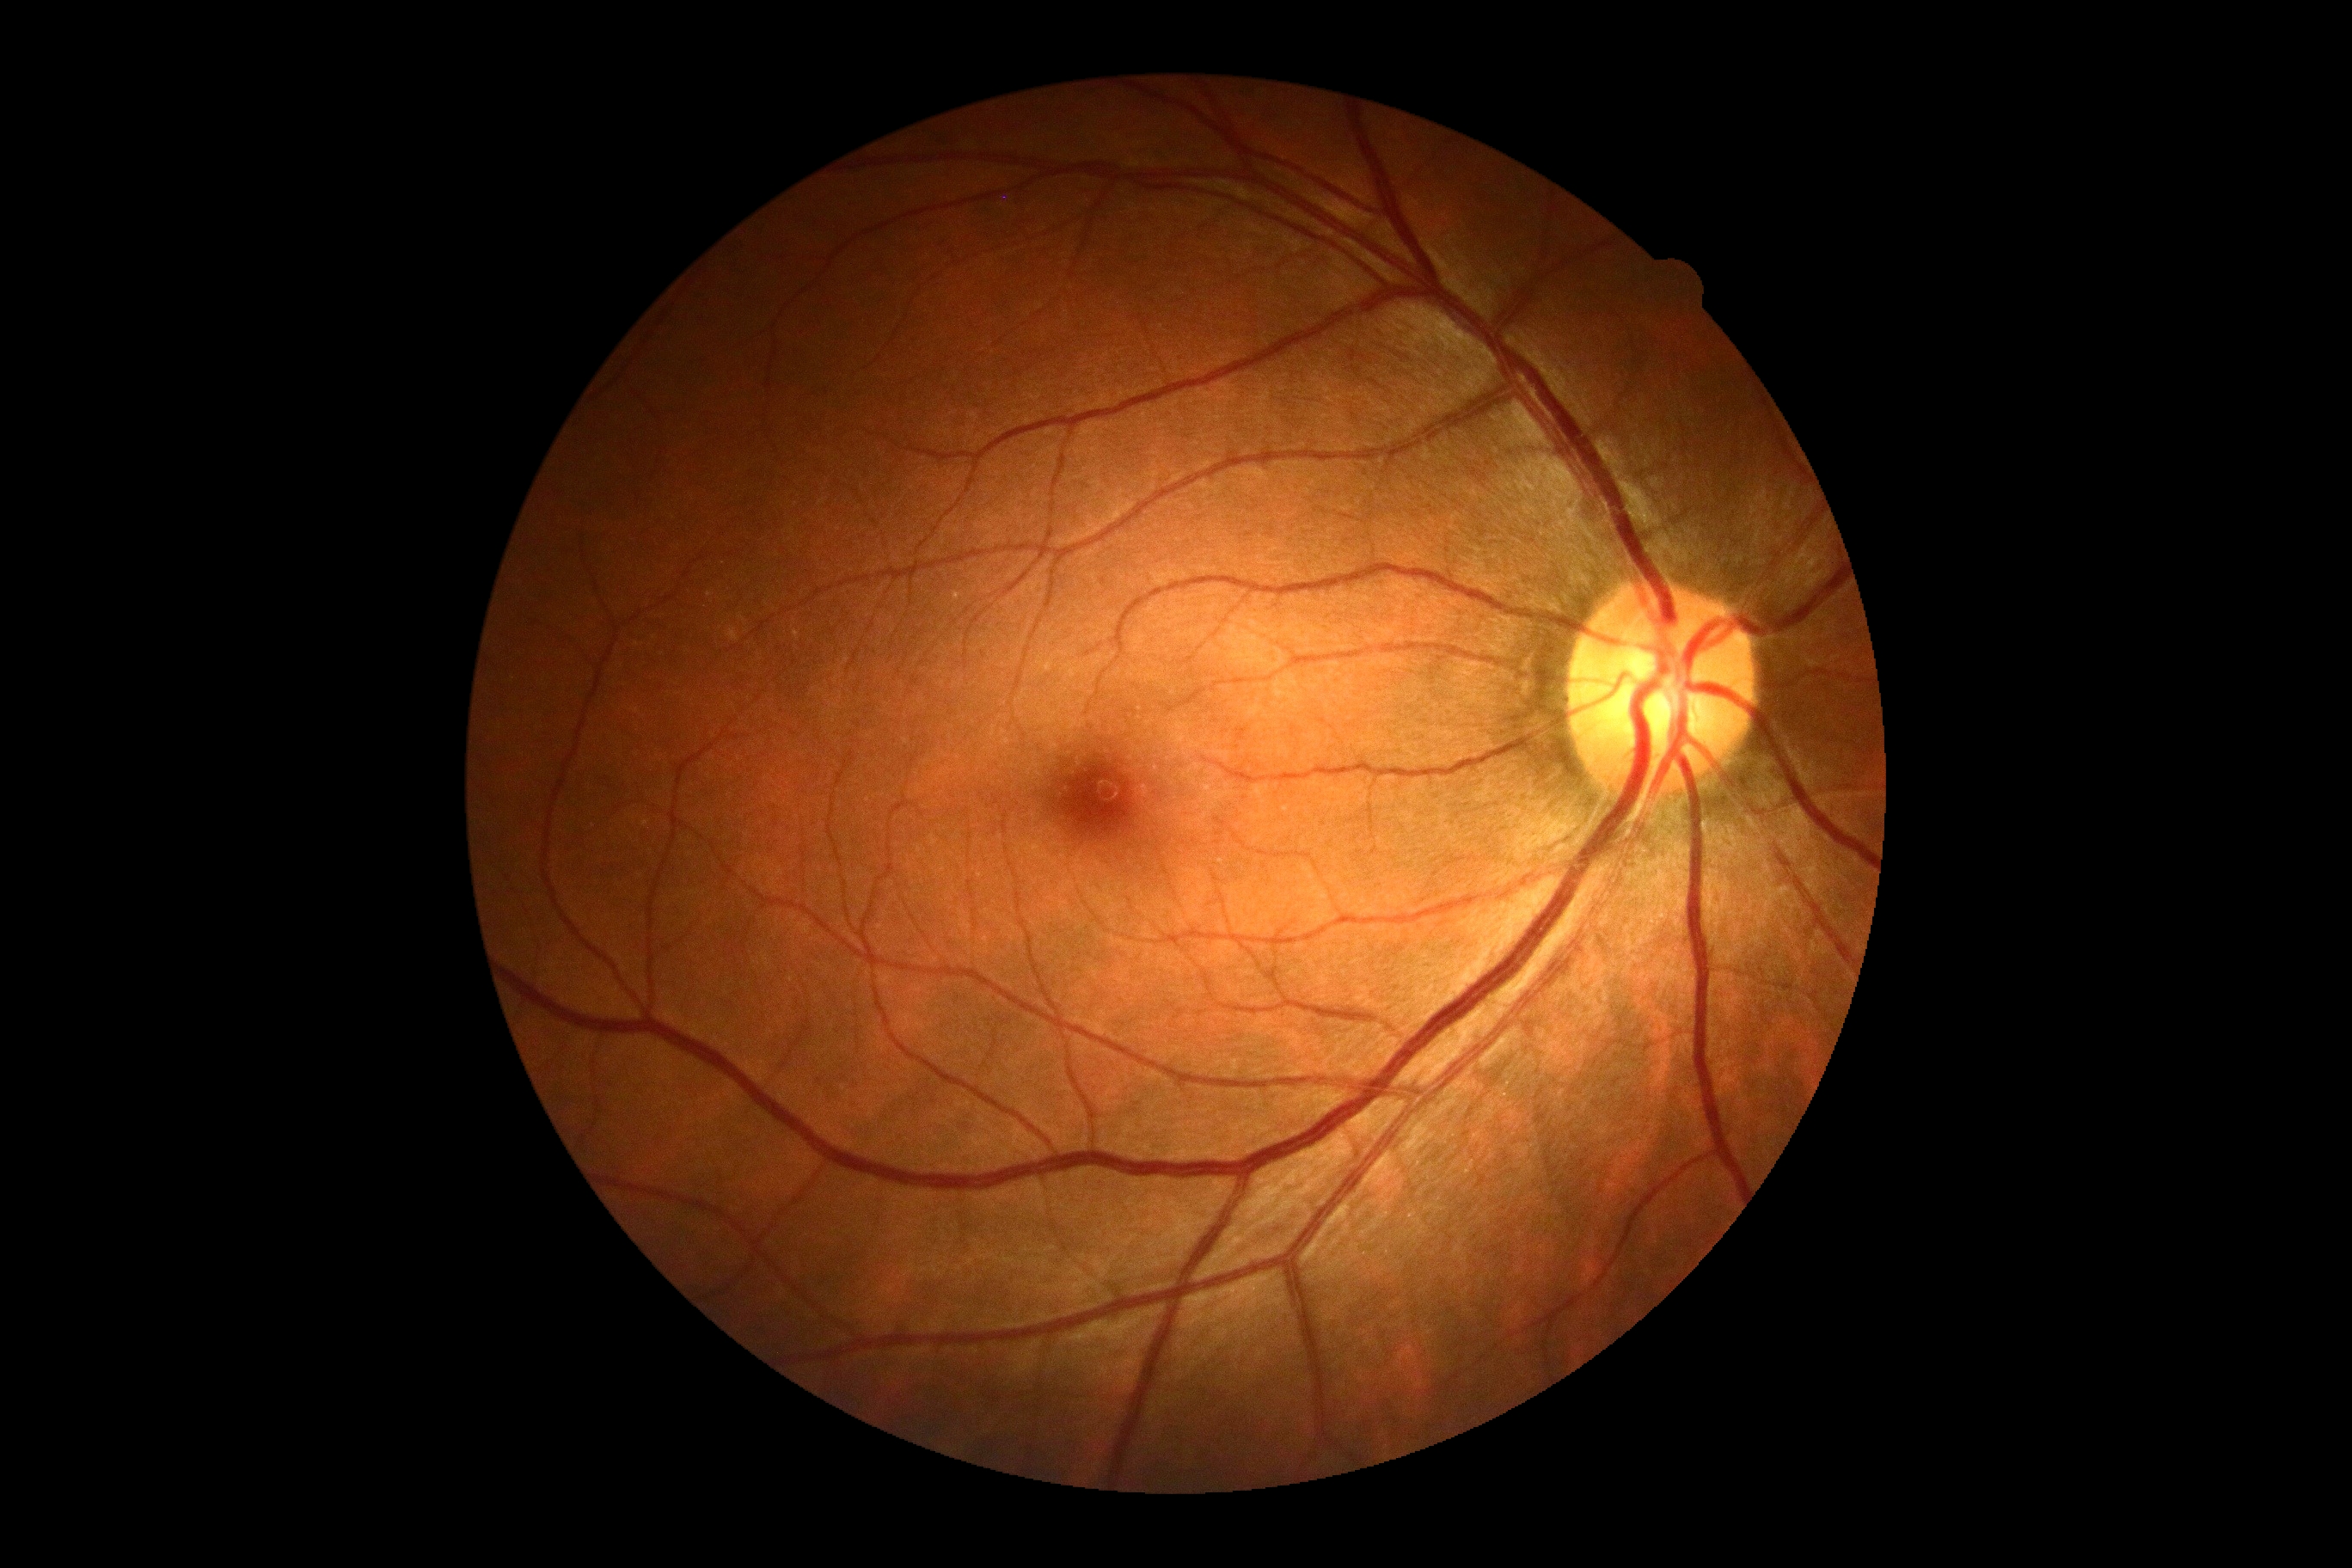
* DR grade — 0/4 — no visible signs of diabetic retinopathy